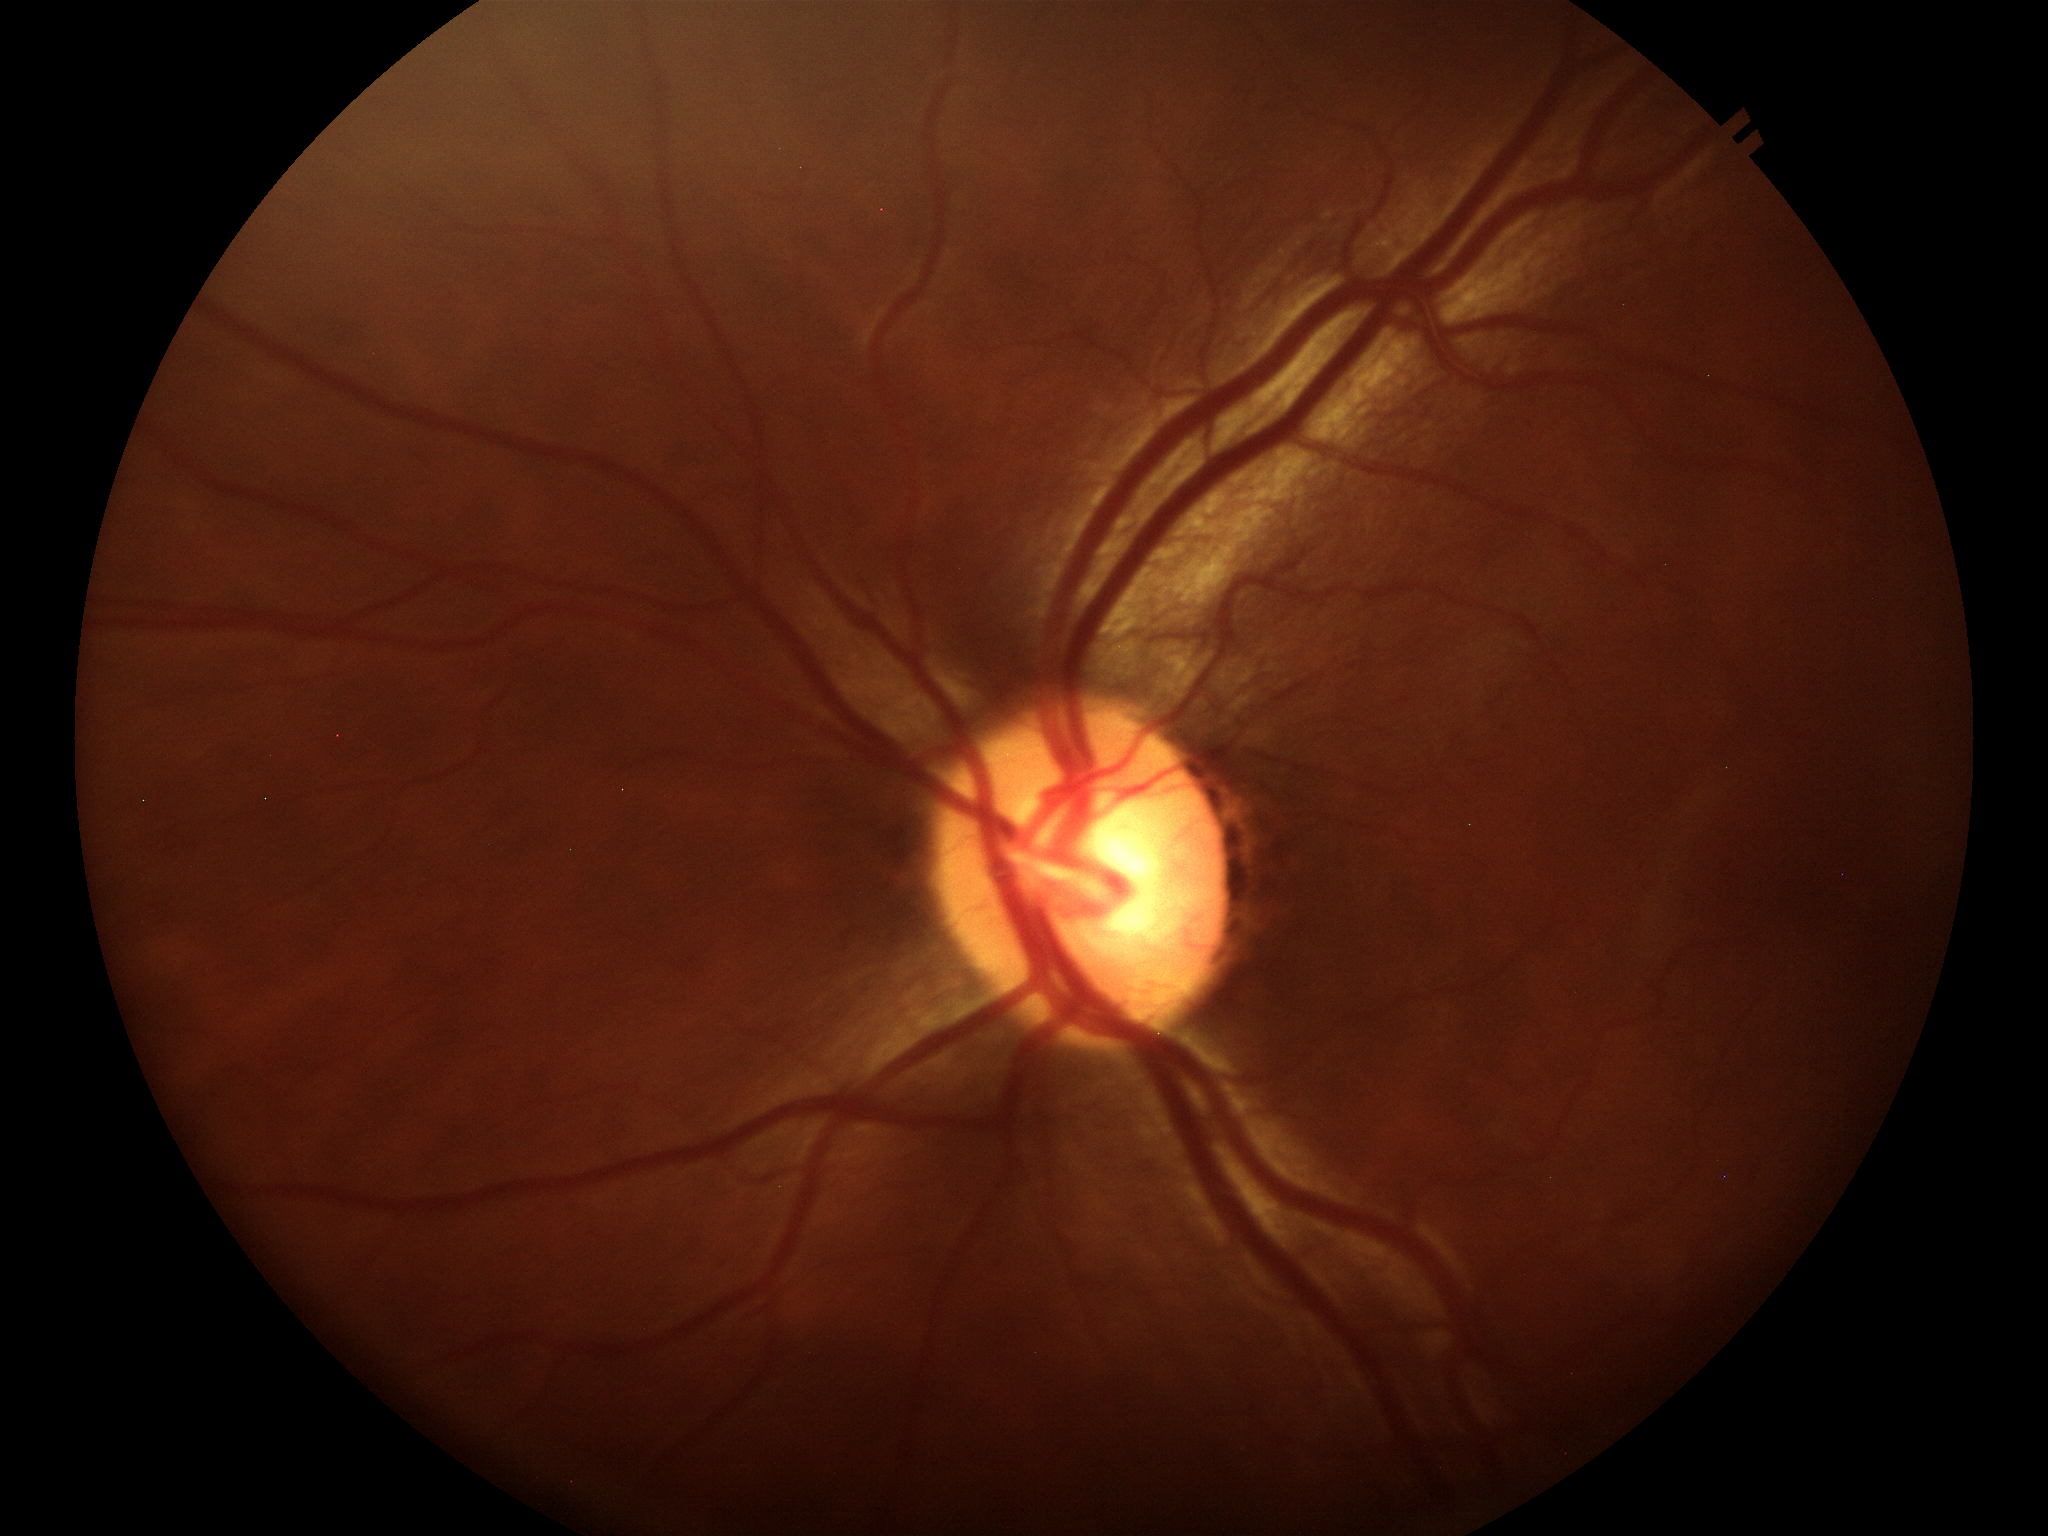 Glaucoma assessment: negative.
Vertical CDR: 0.54.